Camera: Topcon TRC-NW8. Centered on the macula: 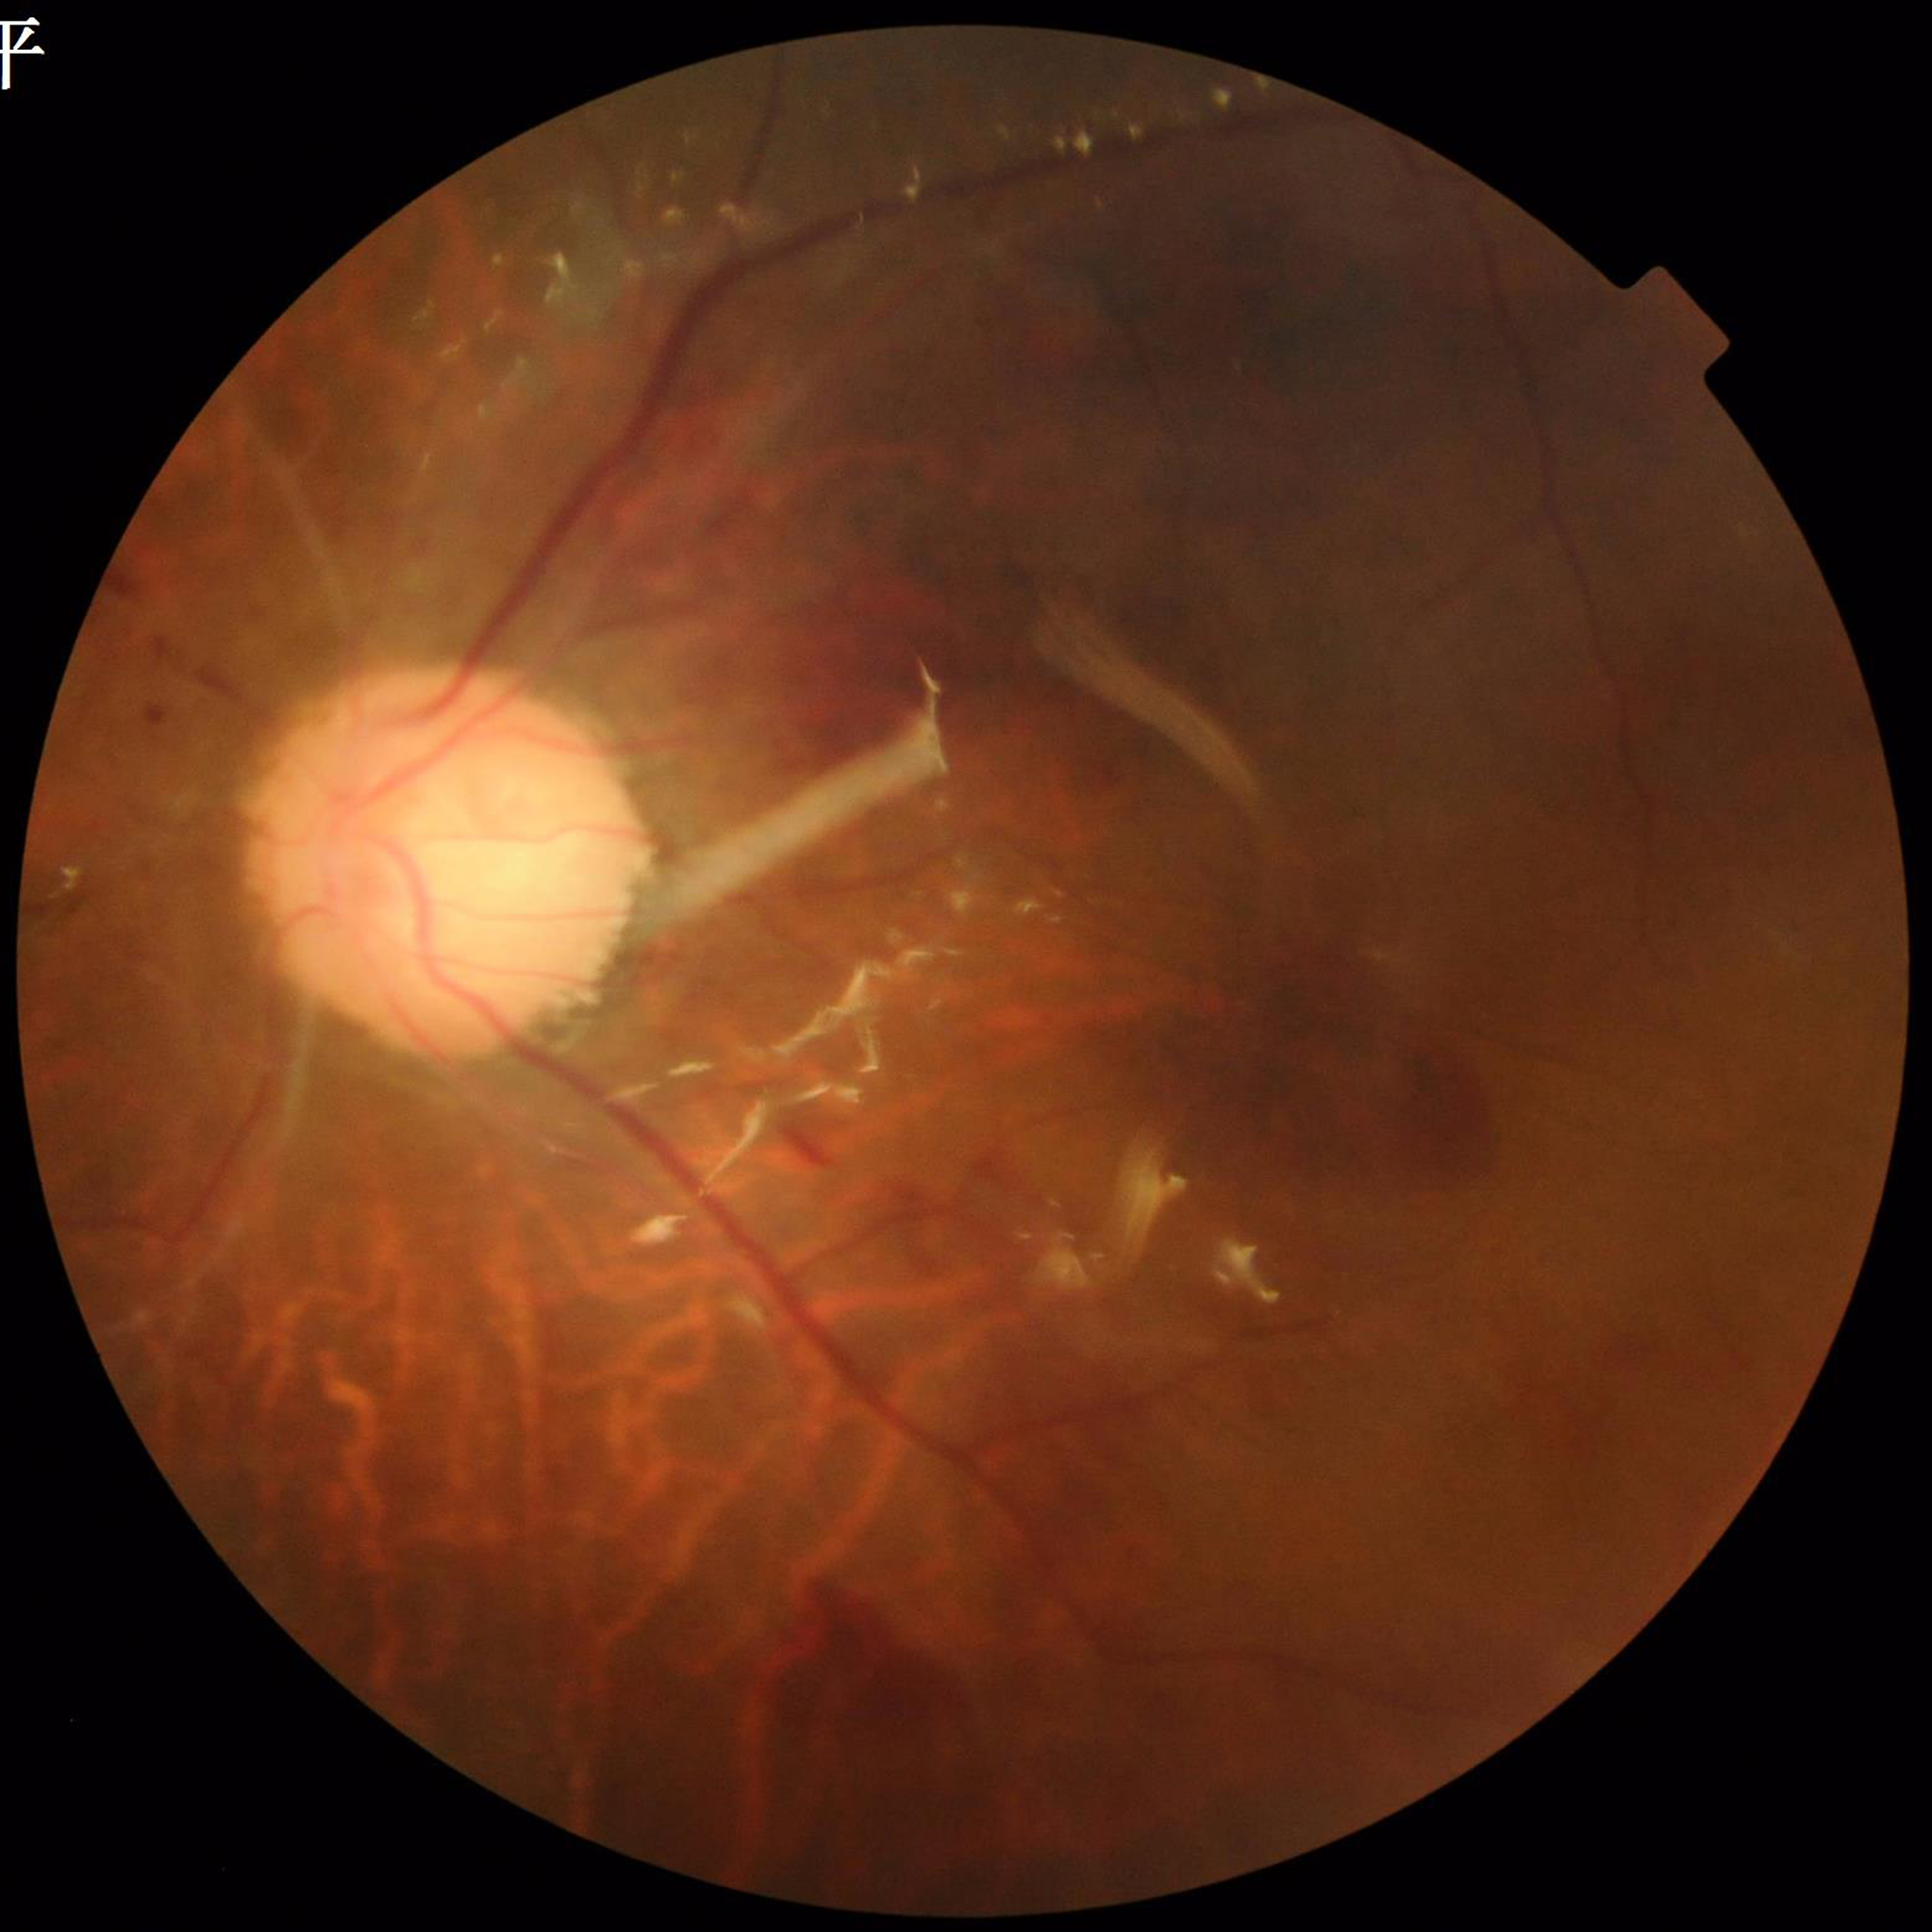

Photo quality = concerns include illumination/color distortion, blur | Diagnosis = diabetic retinopathy (DR).